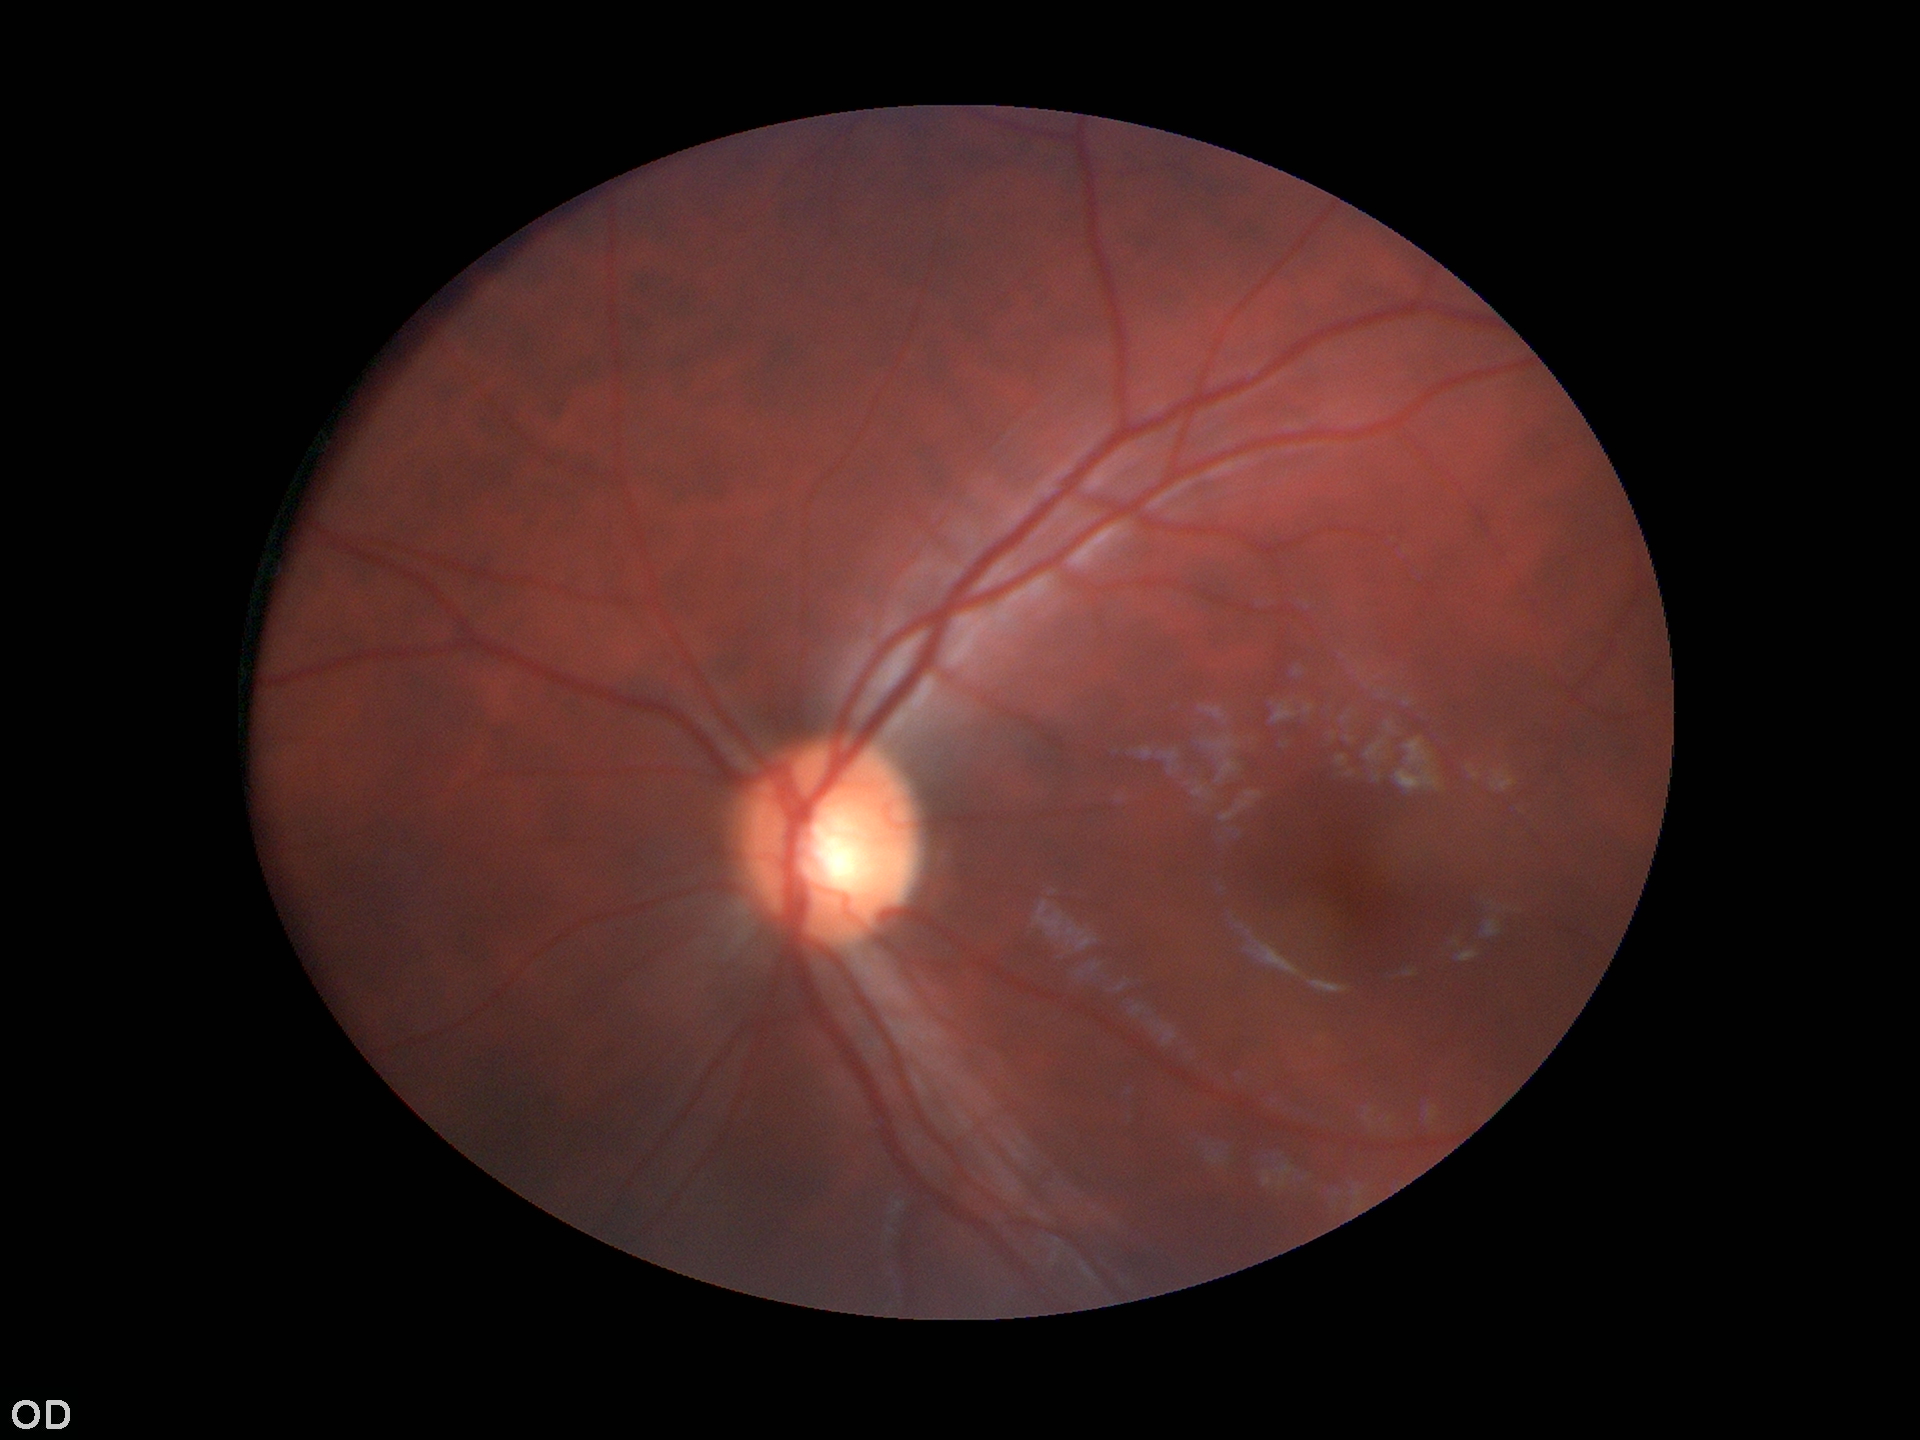

Findings:
• Glaucoma screening · not suspect
• vertical CDR · 0.59